FOV: 45 degrees:
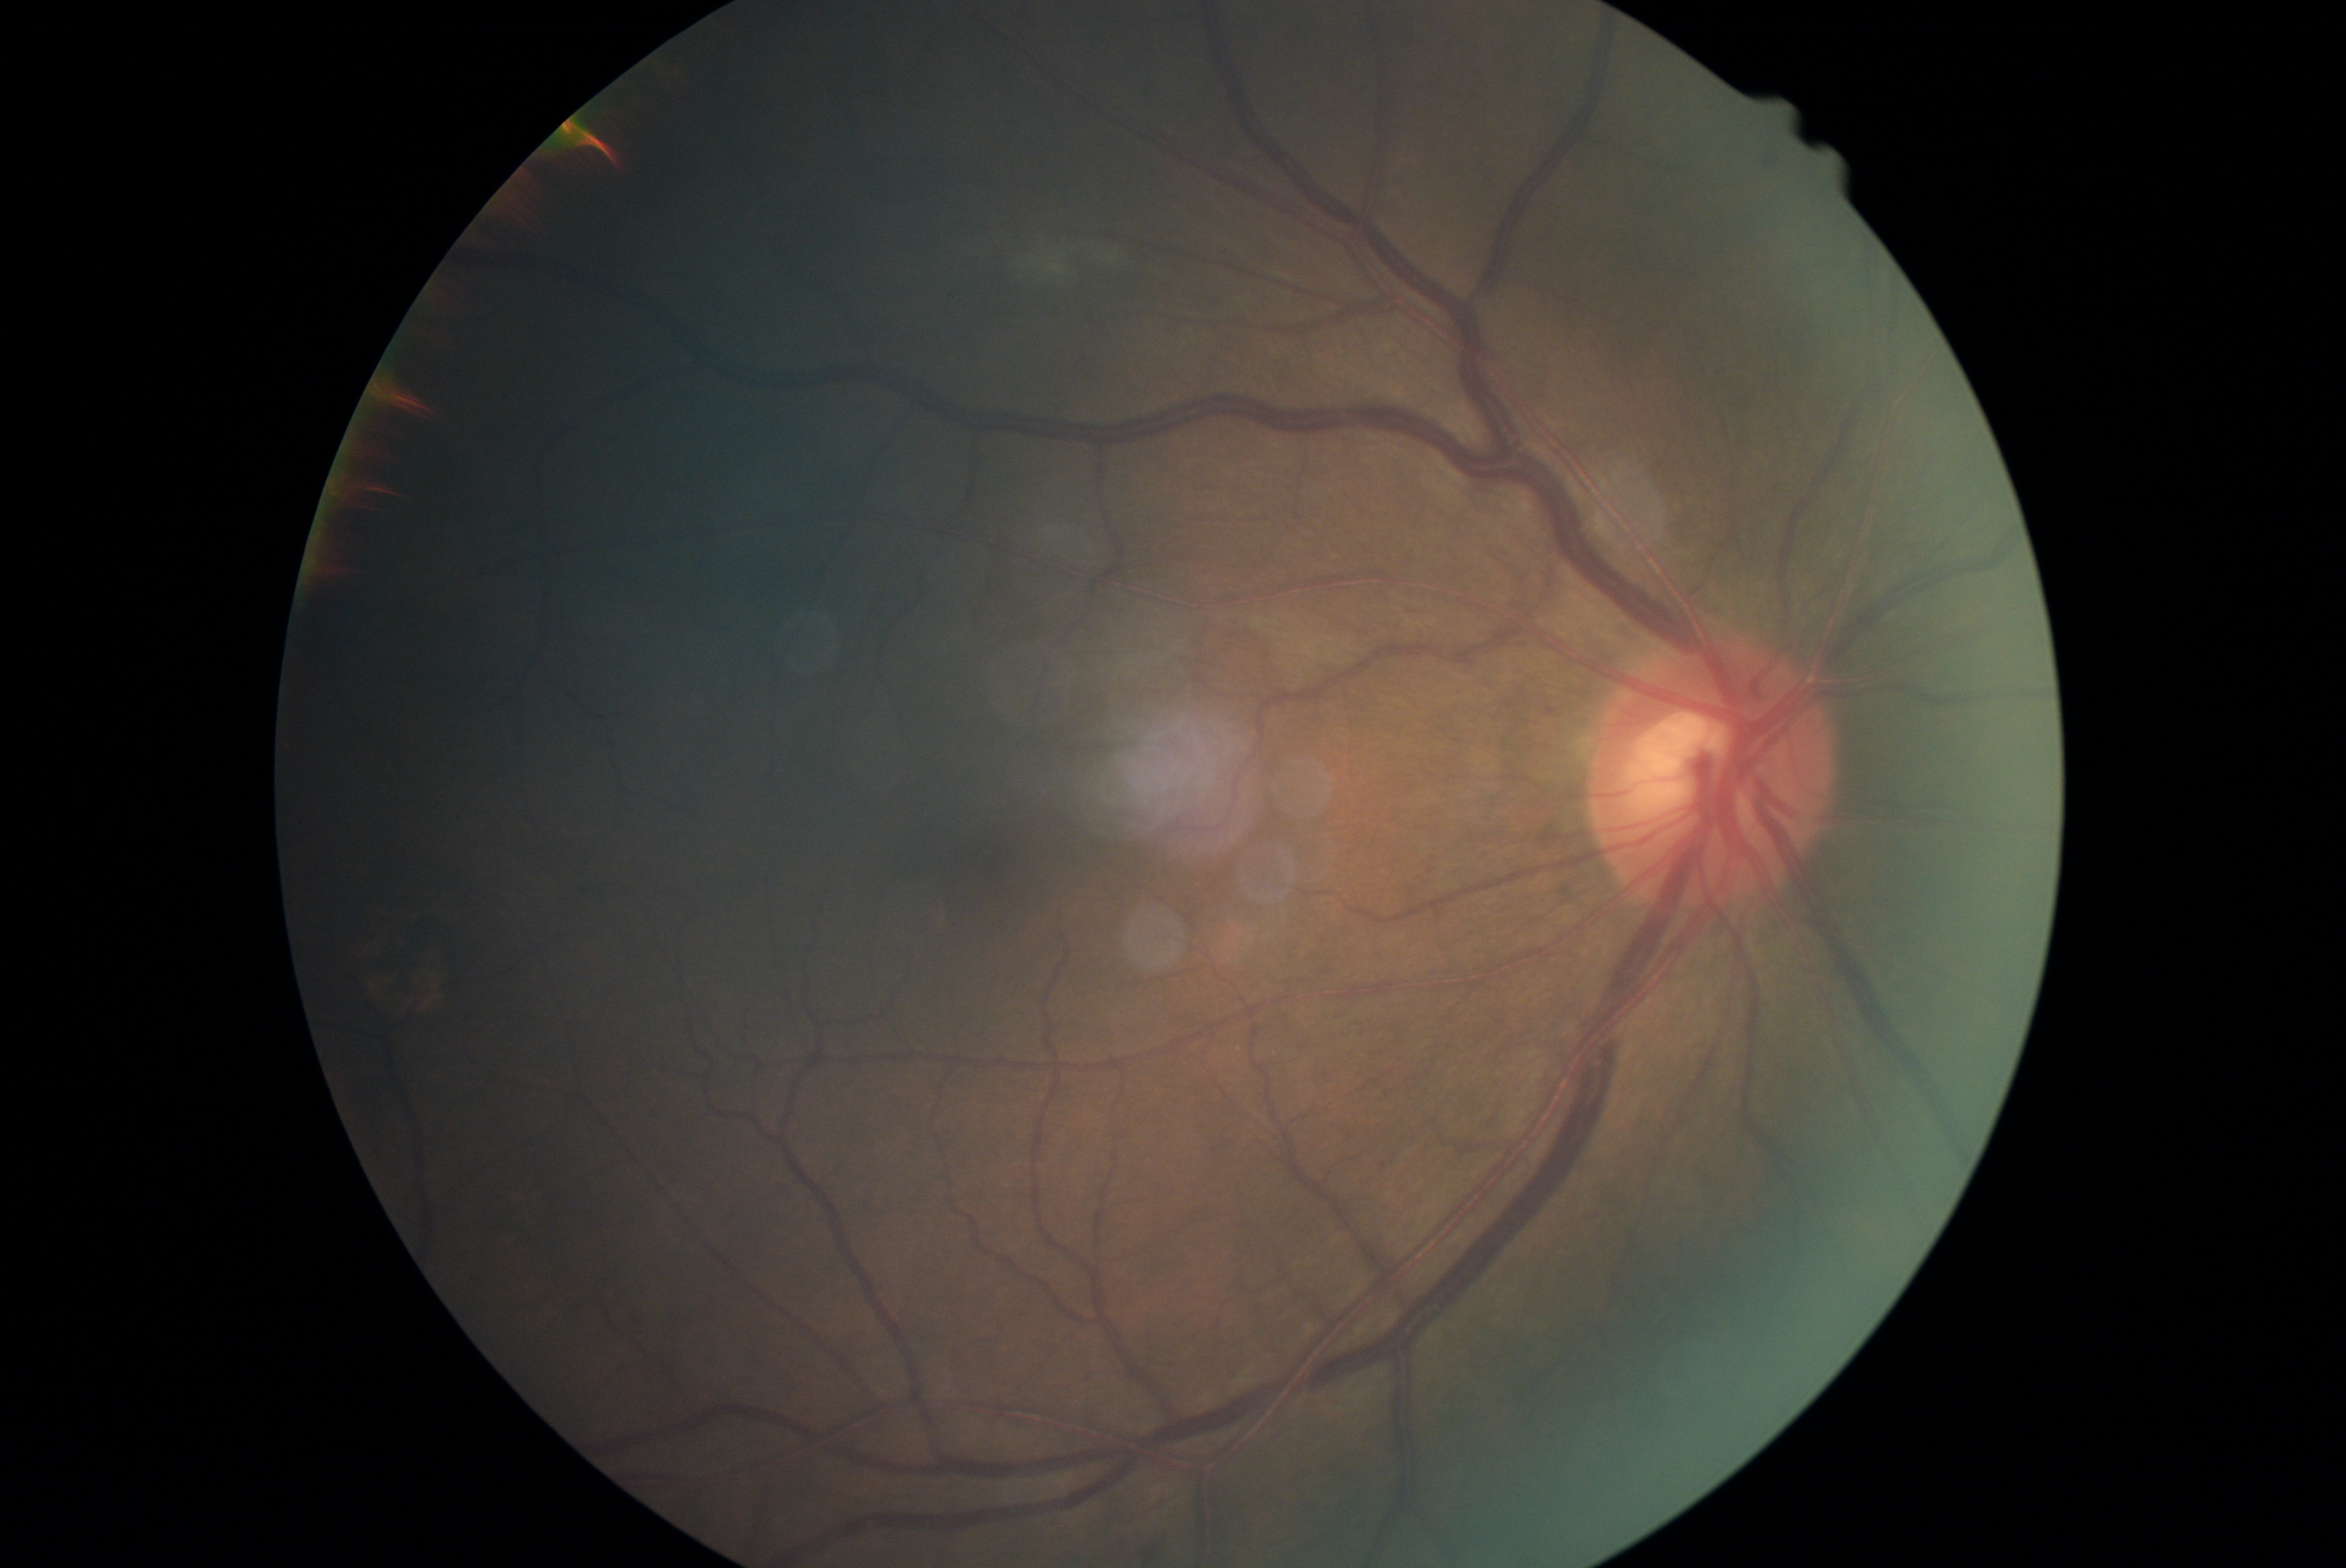
DR severity: grade 2.